Nidek AFC-330 — 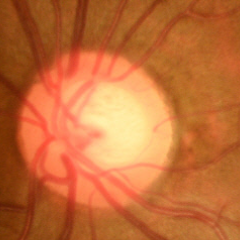 No glaucomatous optic neuropathy.